Modified Davis grading; acquired with a NIDEK AFC-230:
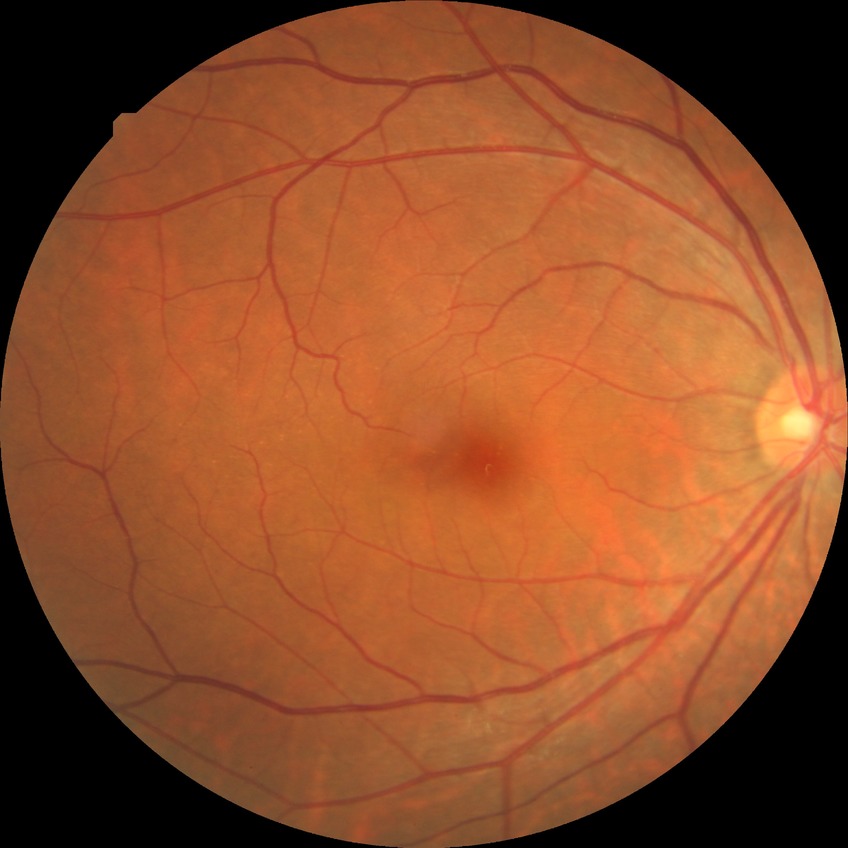
Diabetic retinopathy (DR) is NDR (no diabetic retinopathy).